Color fundus photograph; no pharmacologic dilation; 848x848px; FOV: 45 degrees
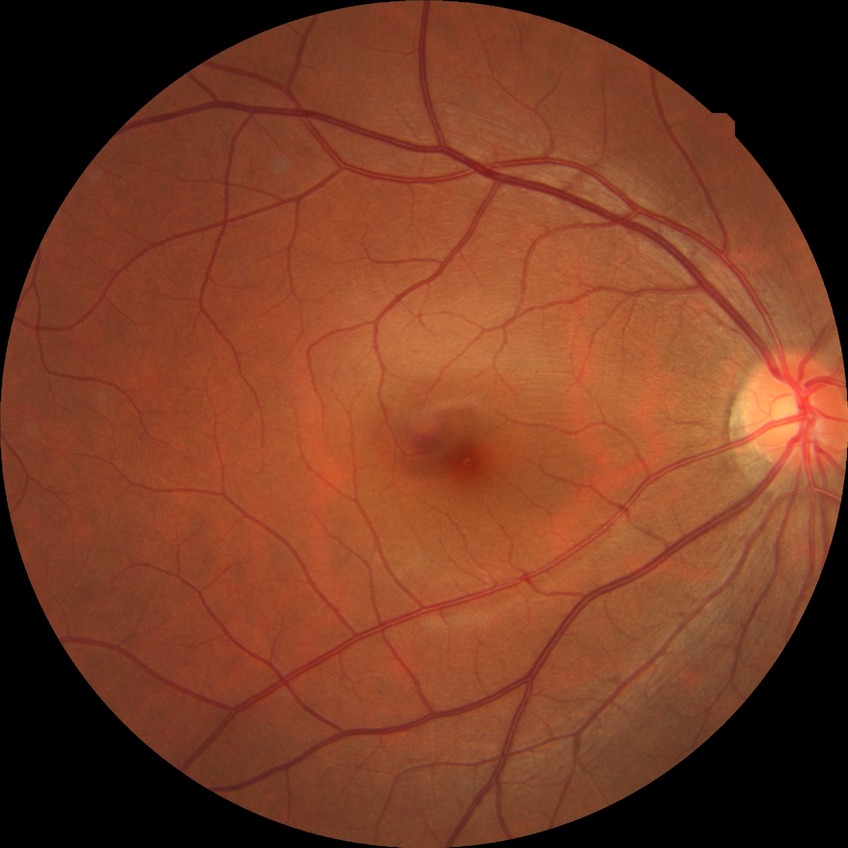 {
  "davis_grade": "NDR"
}